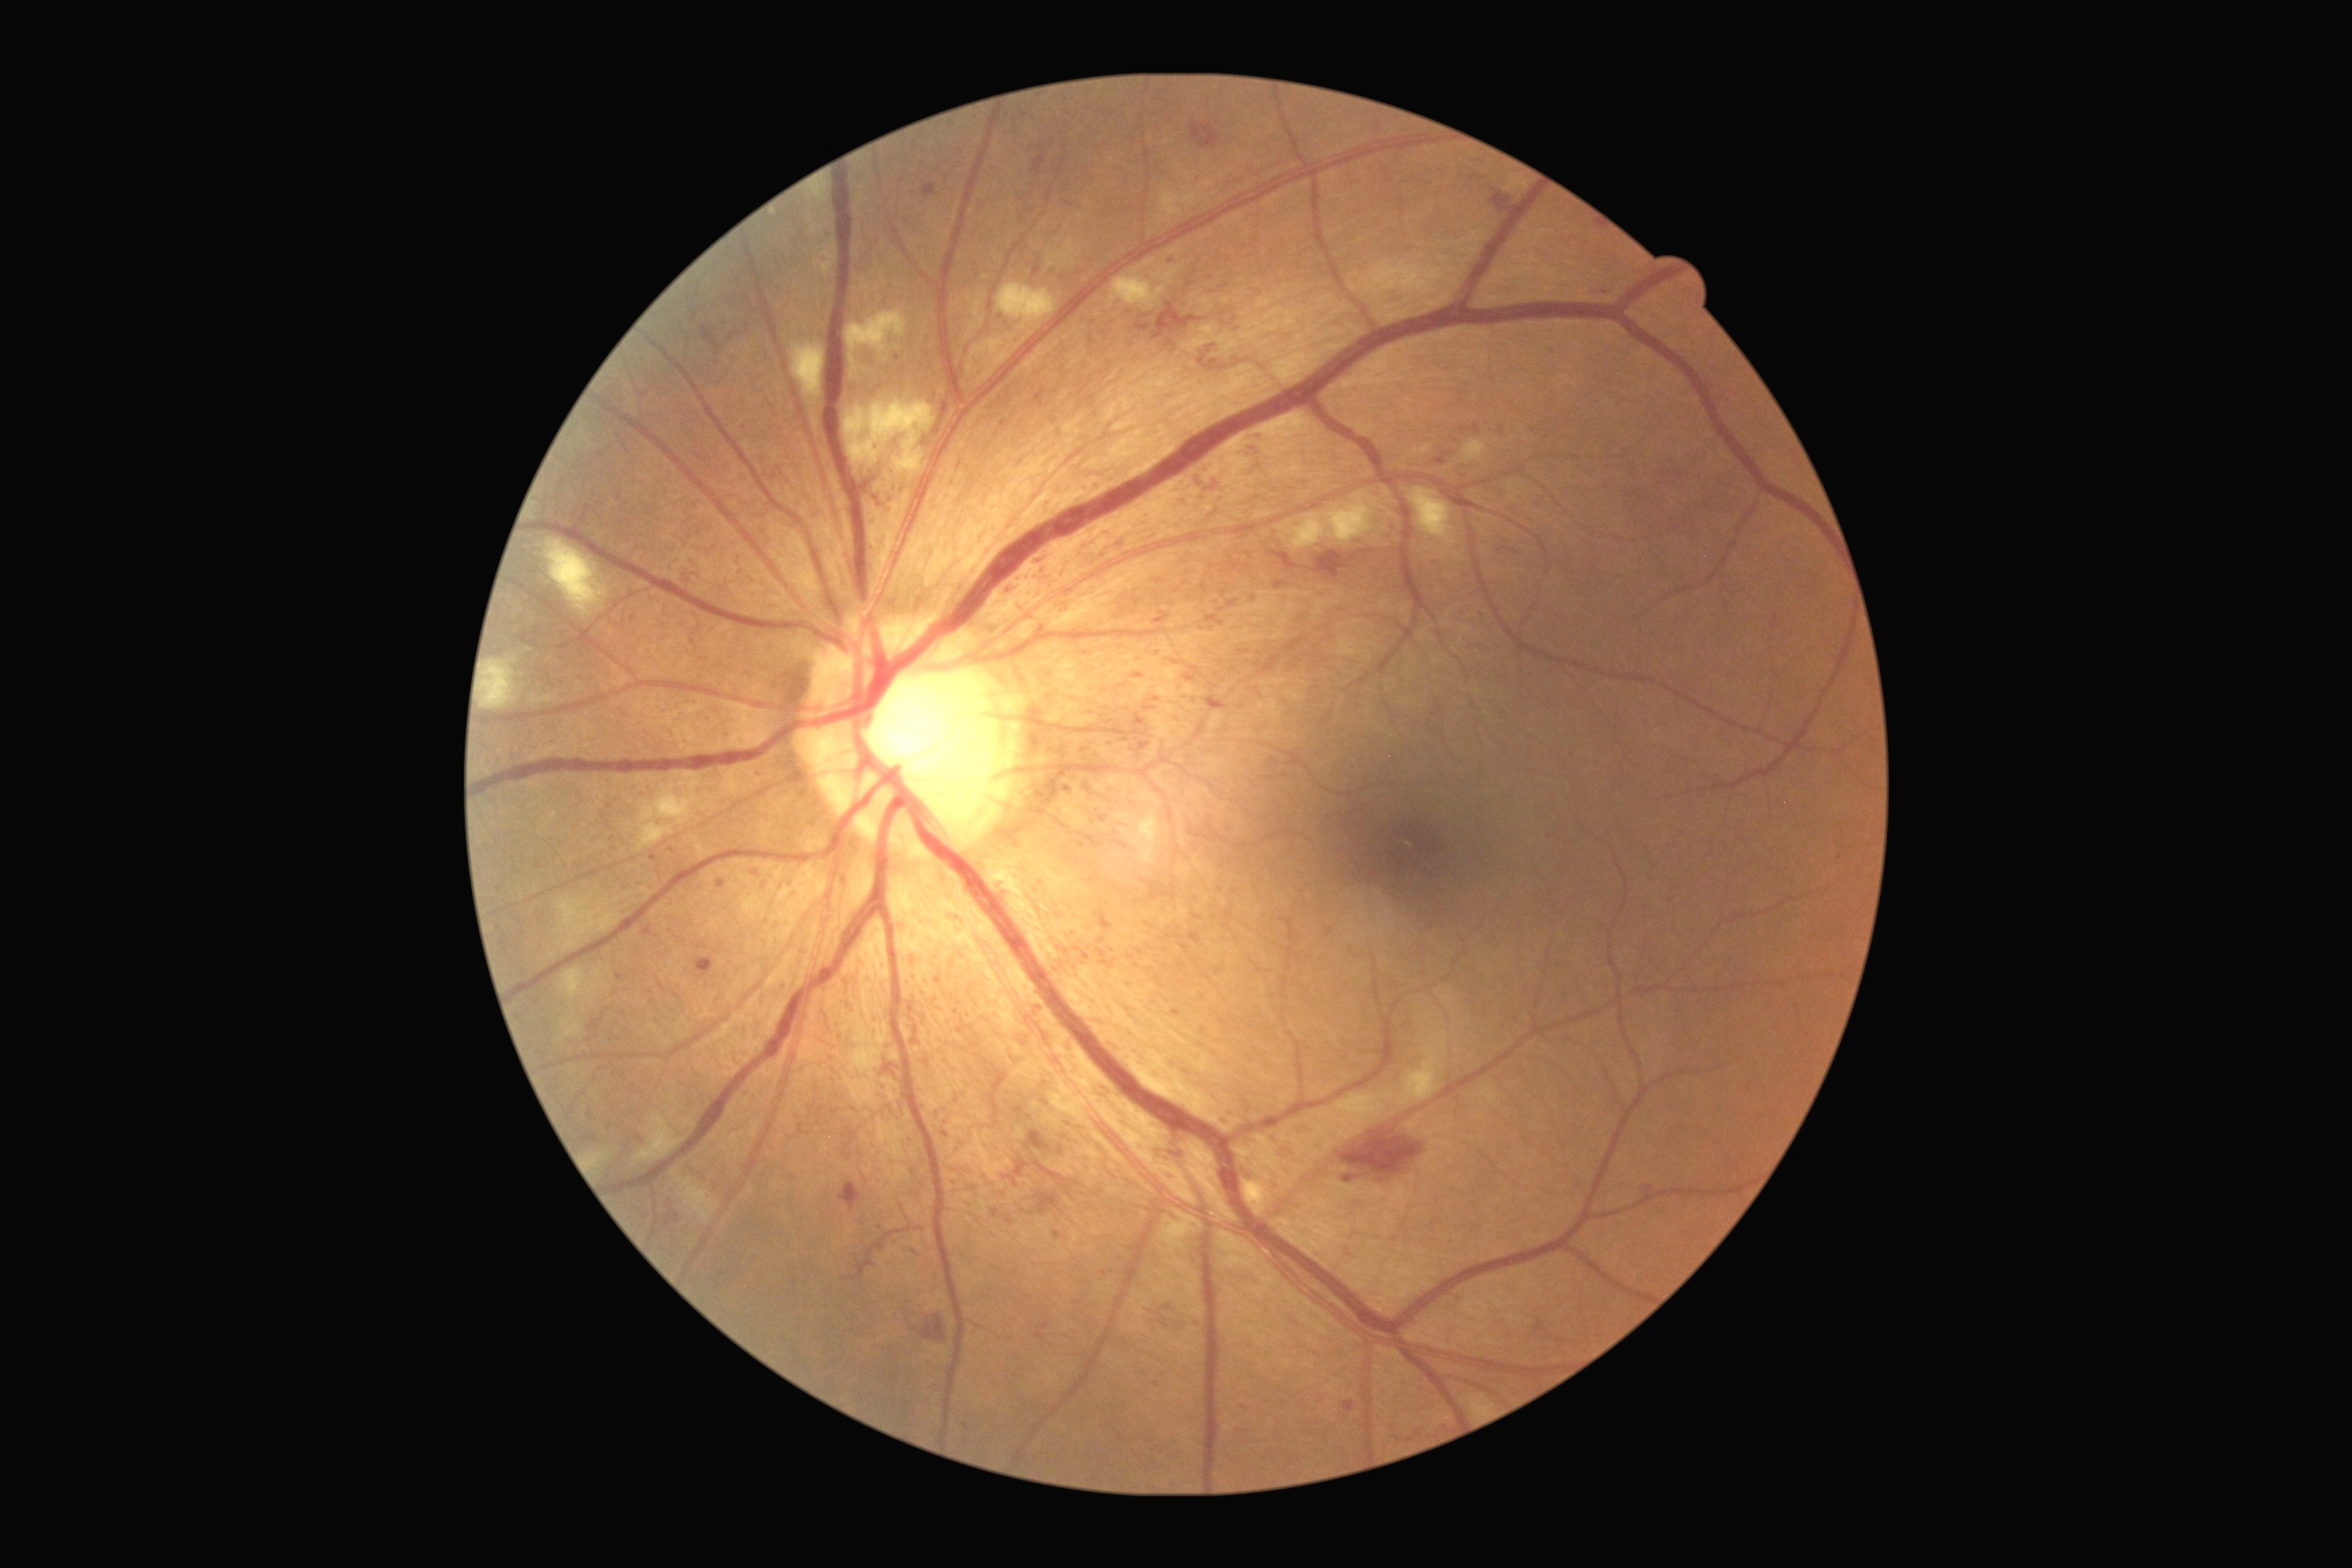

Diabetic retinopathy (DR): 3
Lesions identified (partial list):
hemorrhages (HEs) (partial): [1279, 1142, 1302, 1162]; [874, 496, 881, 505]; [839, 1184, 861, 1213]; [1344, 1175, 1357, 1184]; [1014, 1159, 1030, 1177]; [917, 1315, 948, 1342]; [883, 1064, 901, 1077]; [1217, 476, 1224, 484]; [1493, 193, 1511, 213]; [1181, 496, 1191, 507]; [1340, 1130, 1424, 1182]; [863, 478, 876, 495]; [1199, 355, 1224, 371]; [1026, 1130, 1050, 1152]
hard exudates (EXs): absent
microaneurysms (MAs) (partial): [1037, 1003, 1046, 1017]; [1251, 444, 1260, 455]; [1102, 963, 1115, 966]; [1144, 705, 1155, 710]; [1206, 696, 1228, 712]; [1008, 587, 1015, 596]; [870, 1259, 876, 1268]; [1059, 1146, 1063, 1155]; [1075, 948, 1090, 961]; [1269, 758, 1279, 767]; [1206, 346, 1217, 353]
Small MAs approximately at (1131; 958); (1244; 1407); (915; 1252); (1671; 900); (1064; 1137); (1221; 610); (1025; 116)
soft exudates (SEs) (partial): [845, 402, 936, 475]; [638, 772, 701, 852]; [810, 184, 828, 201]; [995, 282, 1057, 331]; [560, 968, 598, 1001]; [847, 309, 908, 353]; [1398, 1032, 1447, 1106]; [1464, 440, 1487, 464]; [678, 1179, 720, 1222]; [1244, 1181, 1271, 1217]; [1349, 260, 1458, 300]; [634, 1112, 683, 1164]